1240x1240px. Wide-field fundus photograph of an infant: 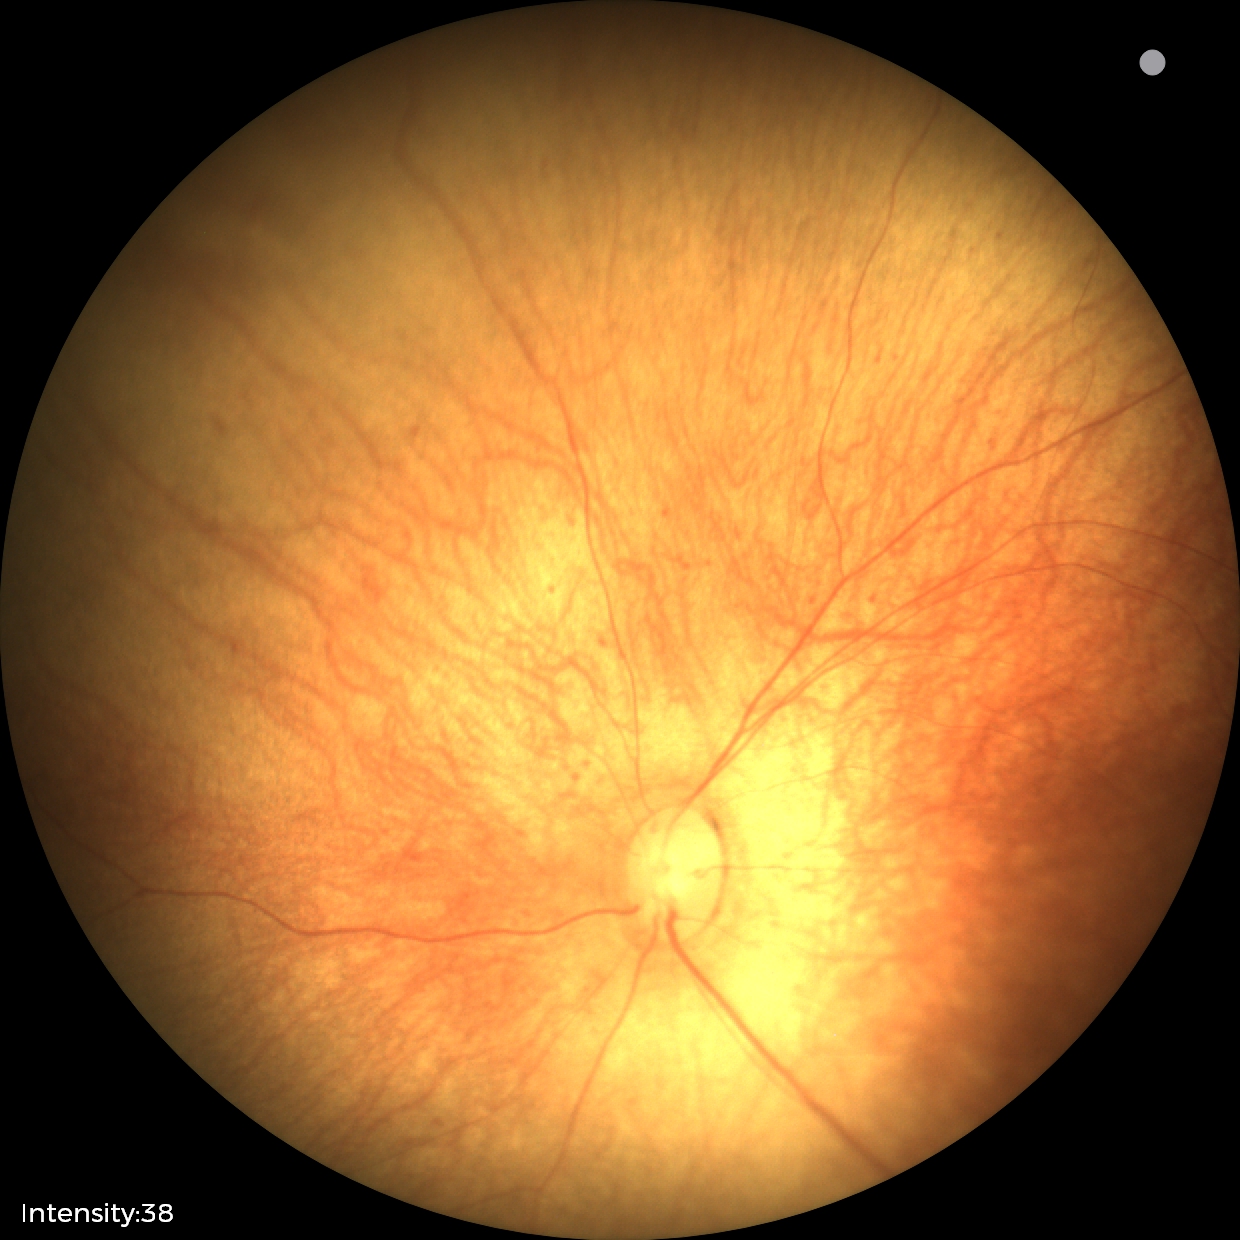

Examination with physiological retinal findings.